45° field of view · graded on the modified Davis scale.
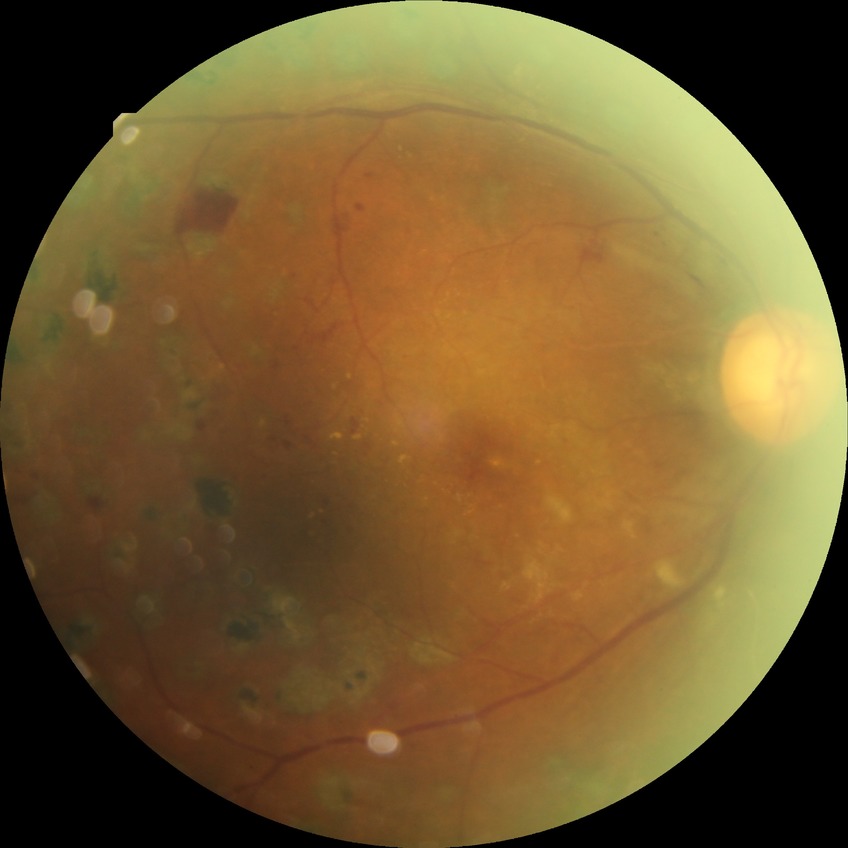 Davis grade: PDR.